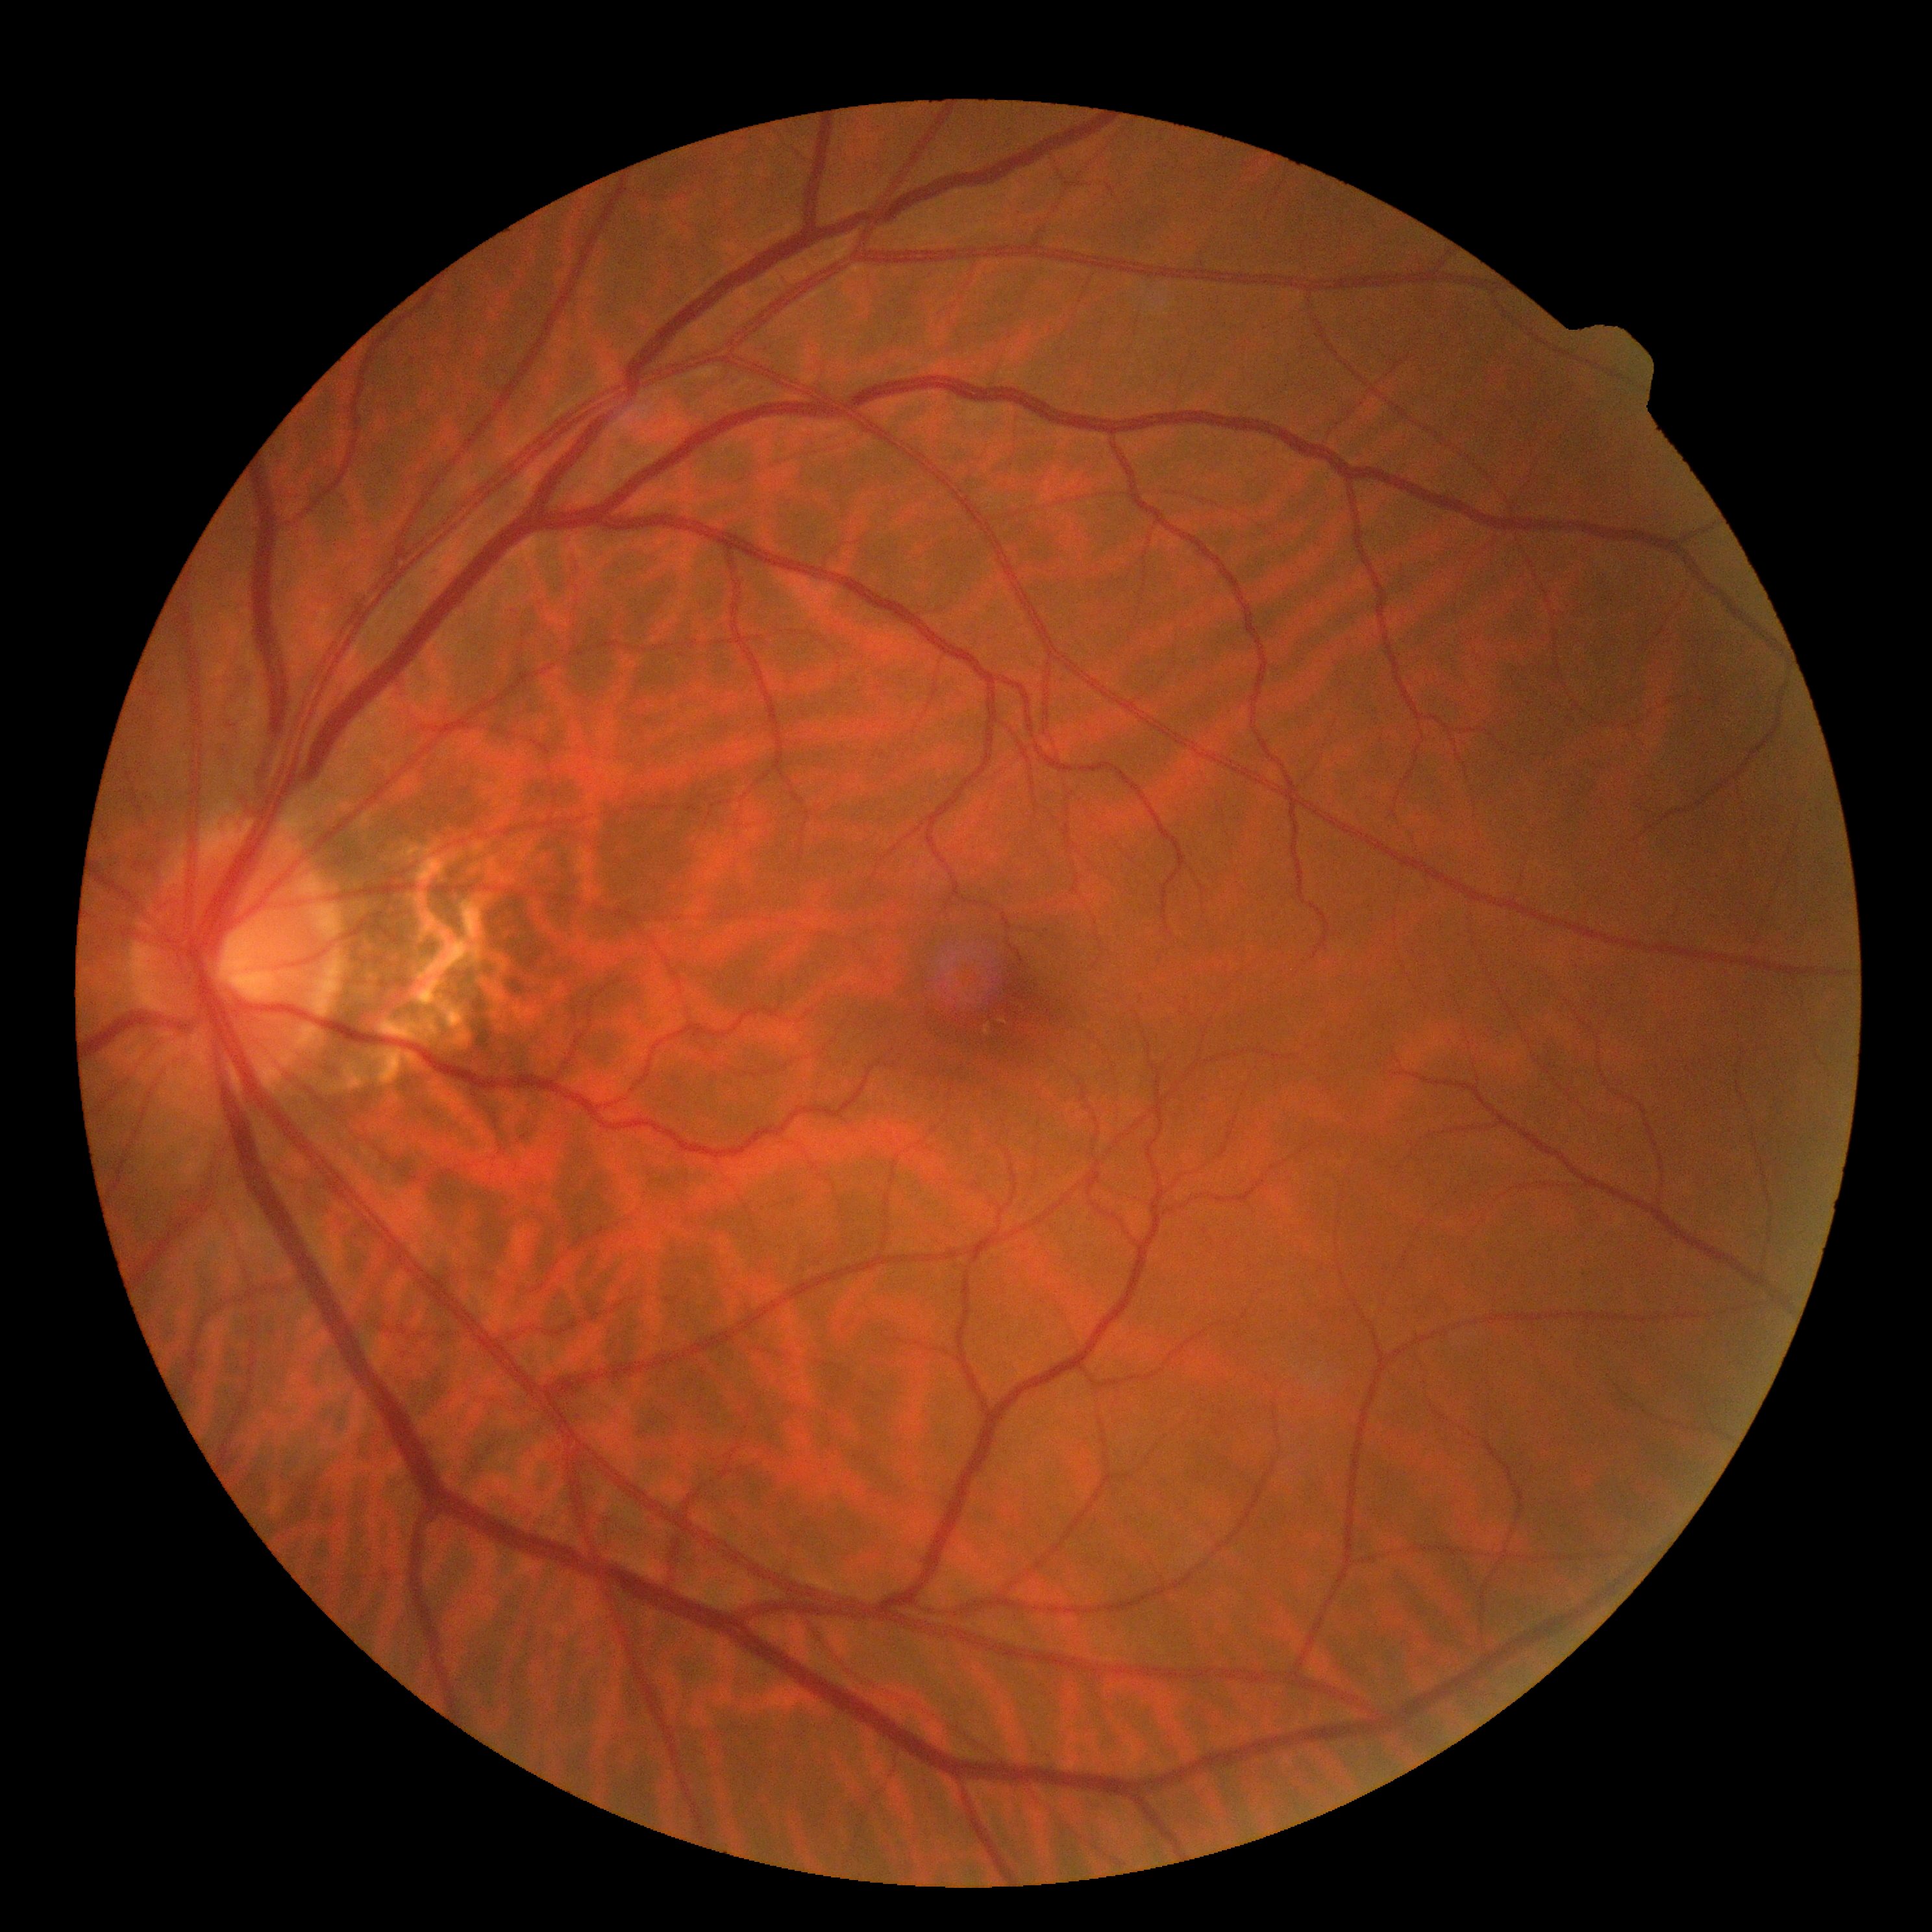
Diabetic retinopathy (DR) is 0.